Macula at the center of the field; 50° field of view — 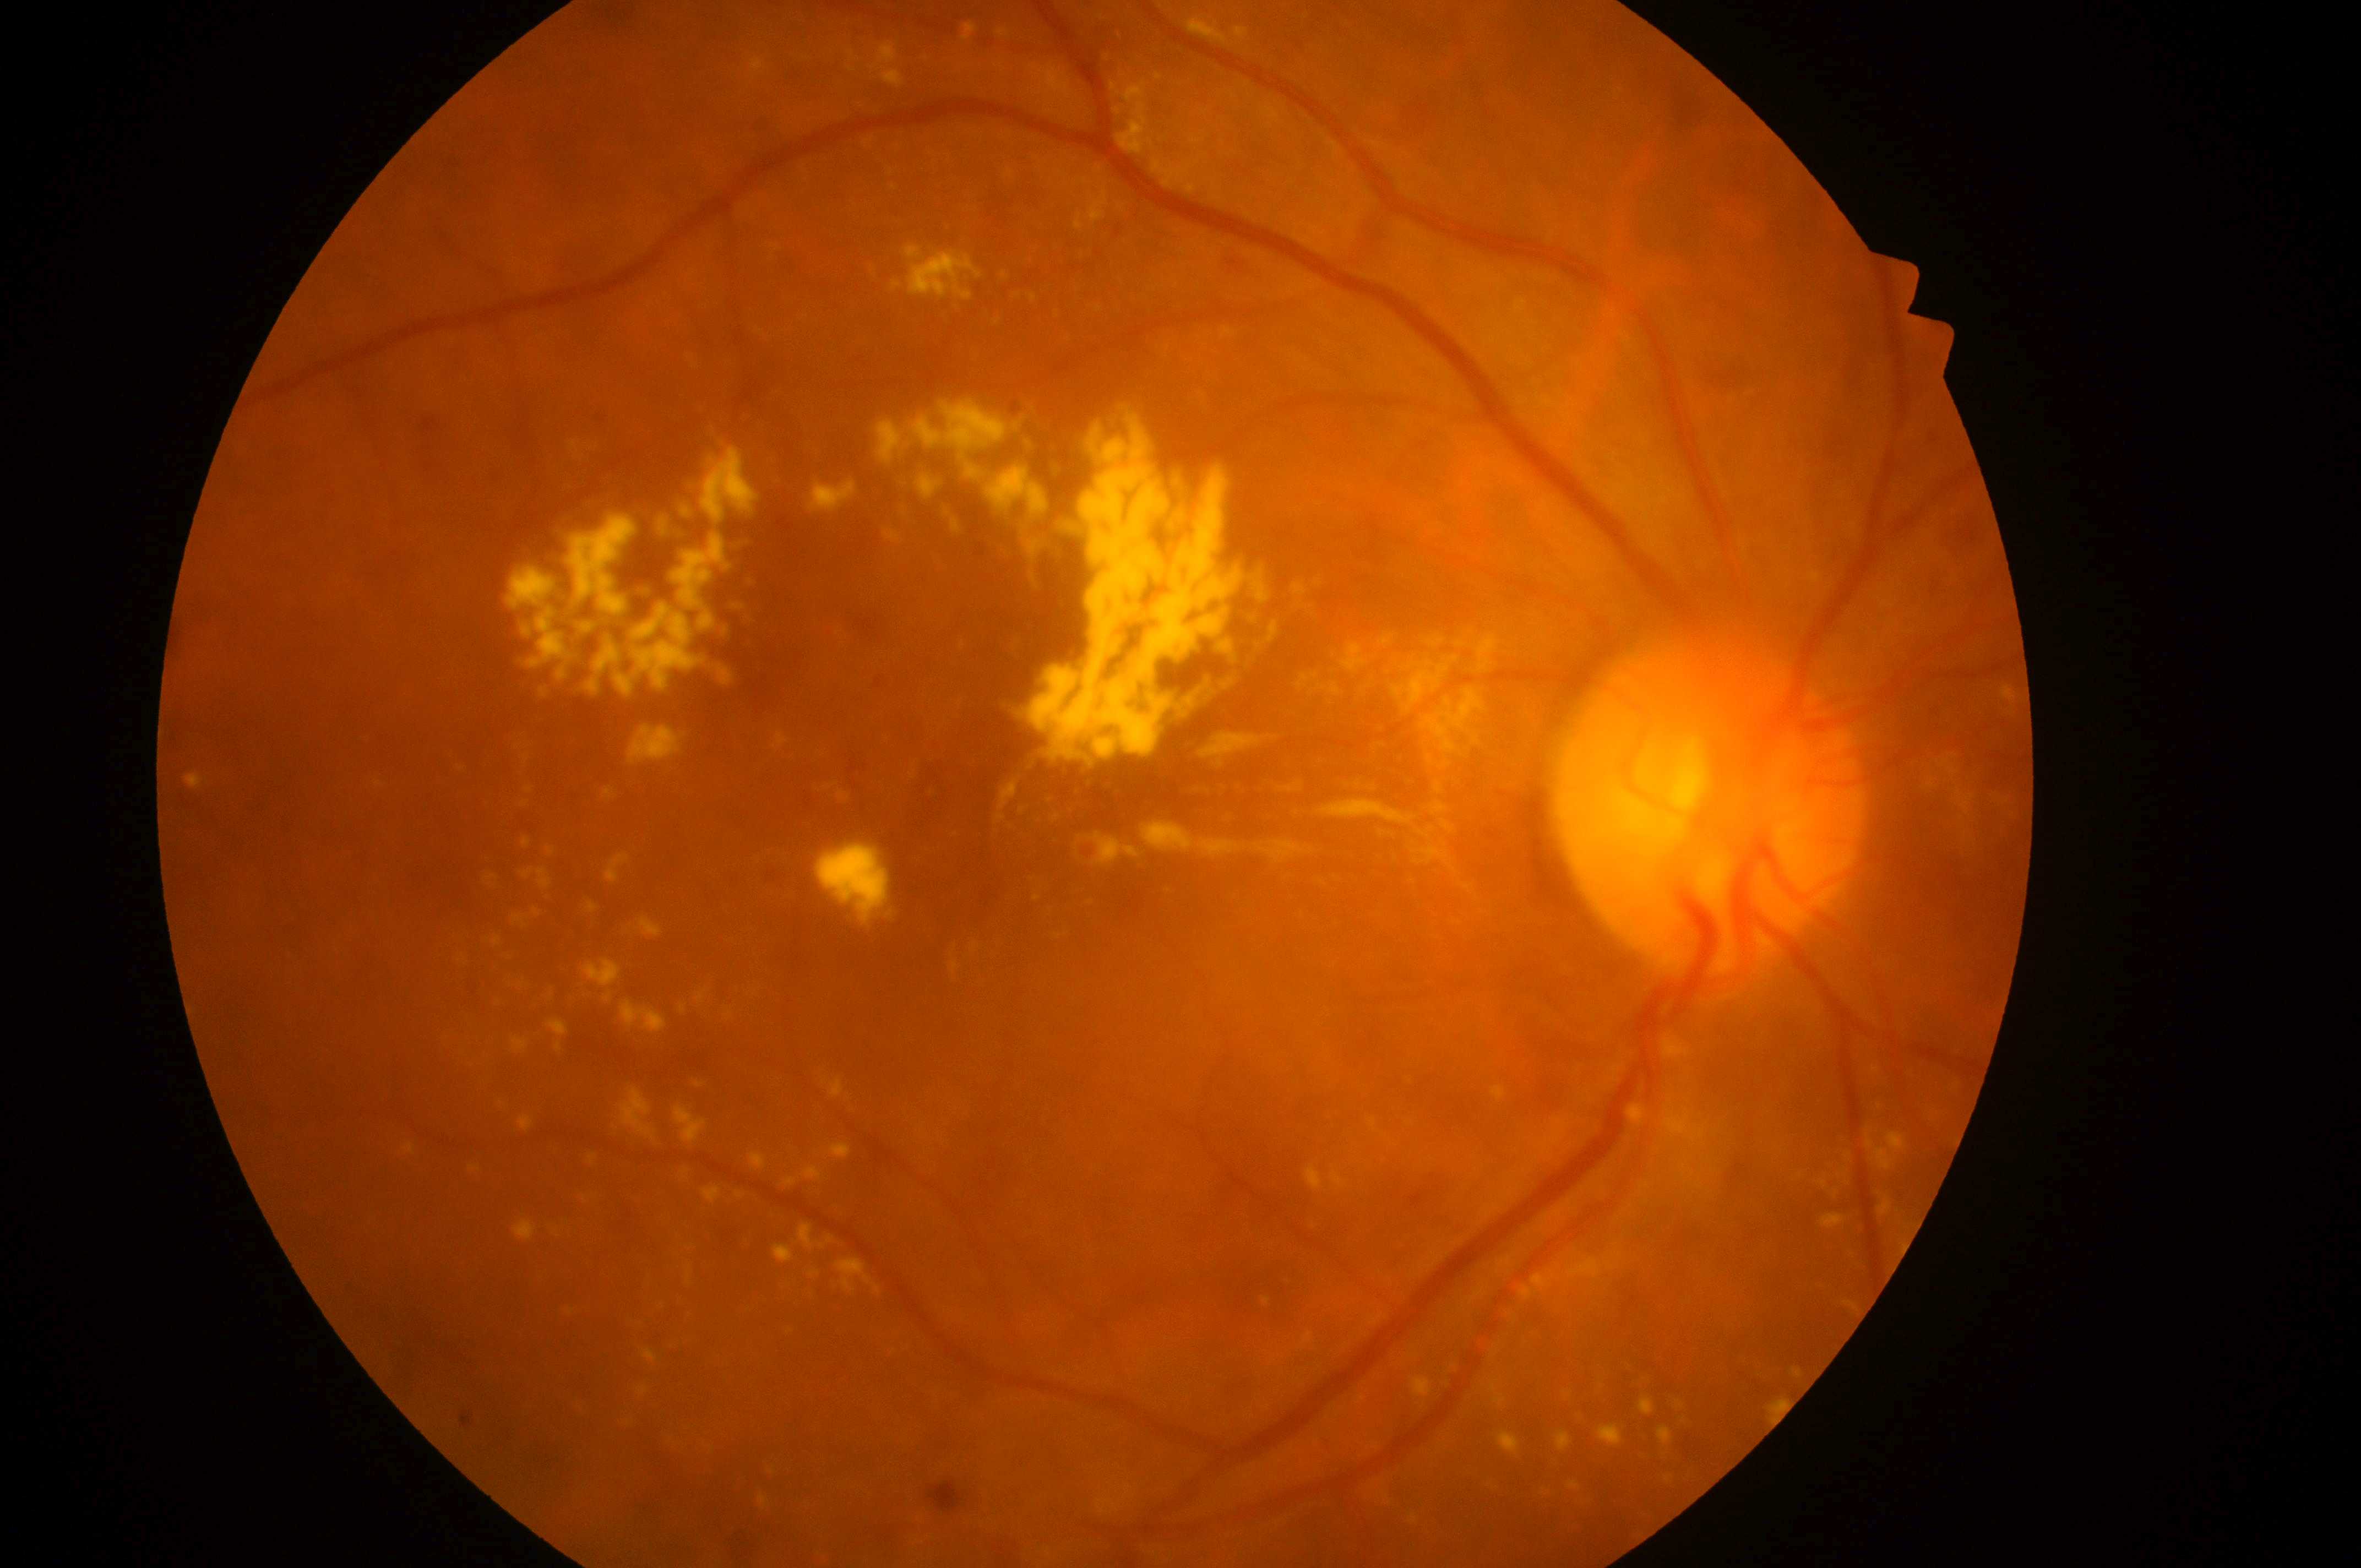

Findings:
- laterality: right
- DR class: proliferative diabetic retinopathy
- optic disk: x=1708, y=814
- diabetic macular edema (DME): grade 2 — hard exudates within one disc diameter of the macula center
- fovea: x=1019, y=835
- diabetic retinopathy (DR): grade 4 — neovascularization and/or vitreous/pre-retinal hemorrhage